848x848; nonmydriatic fundus photograph: 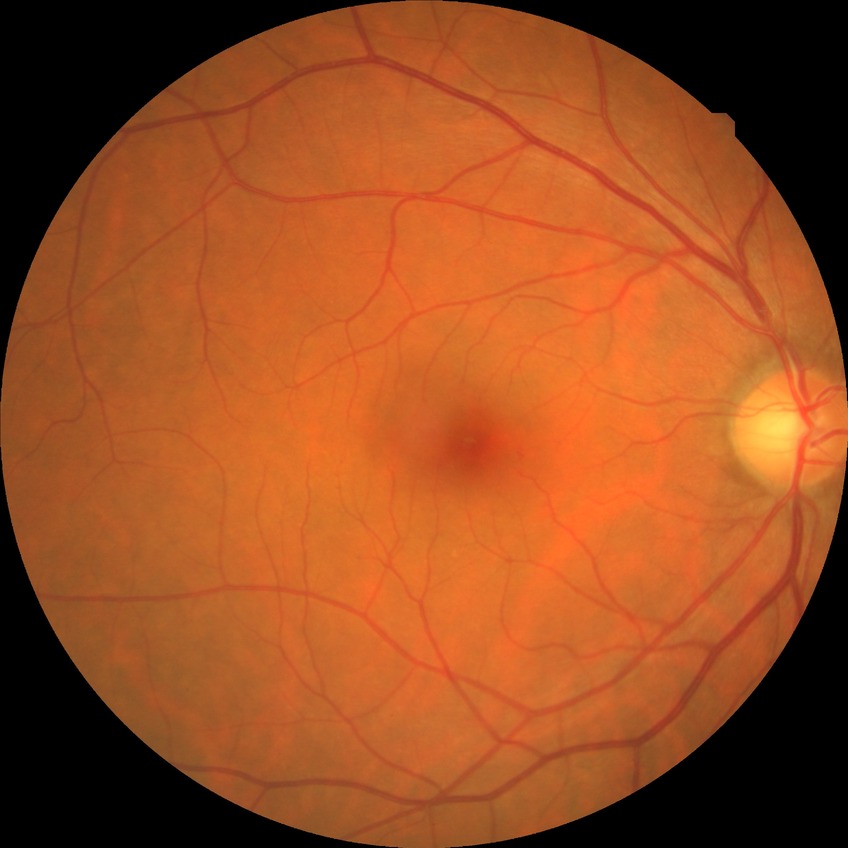

diabetic retinopathy (DR): NDR (no diabetic retinopathy)